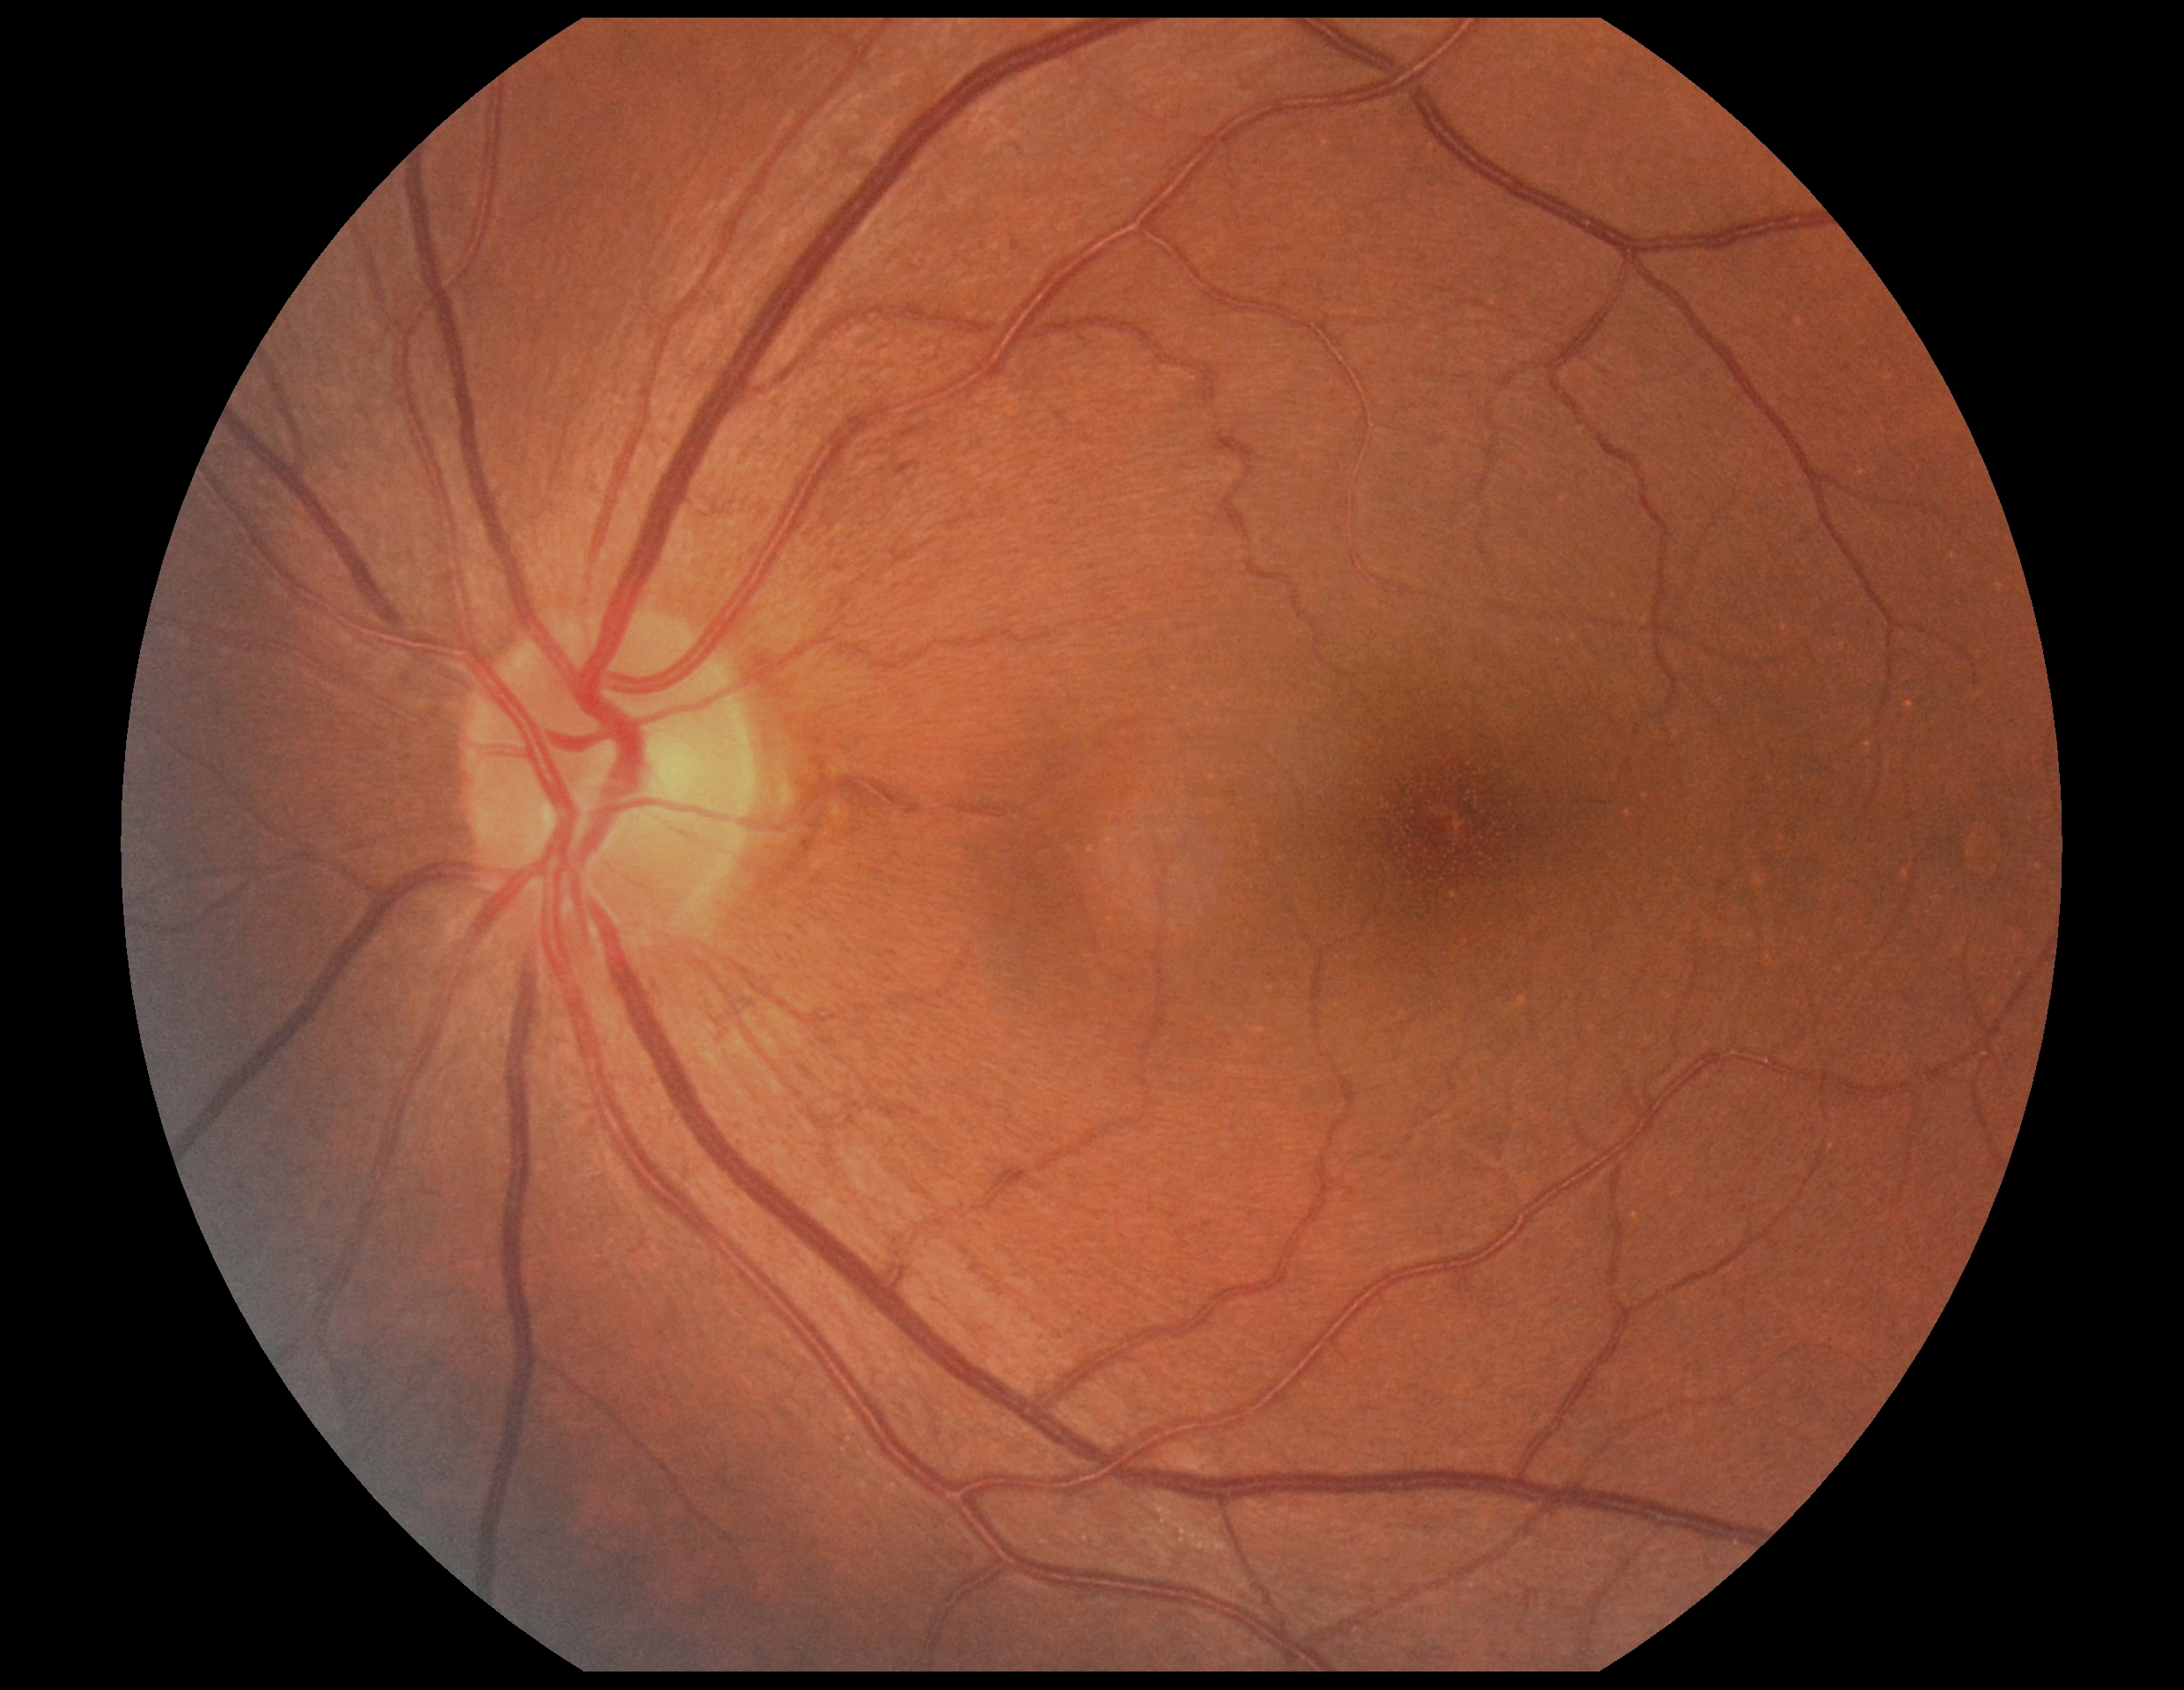
DR grade is 0 (no apparent retinopathy).
No DR findings.